2361x1568 · CFP:
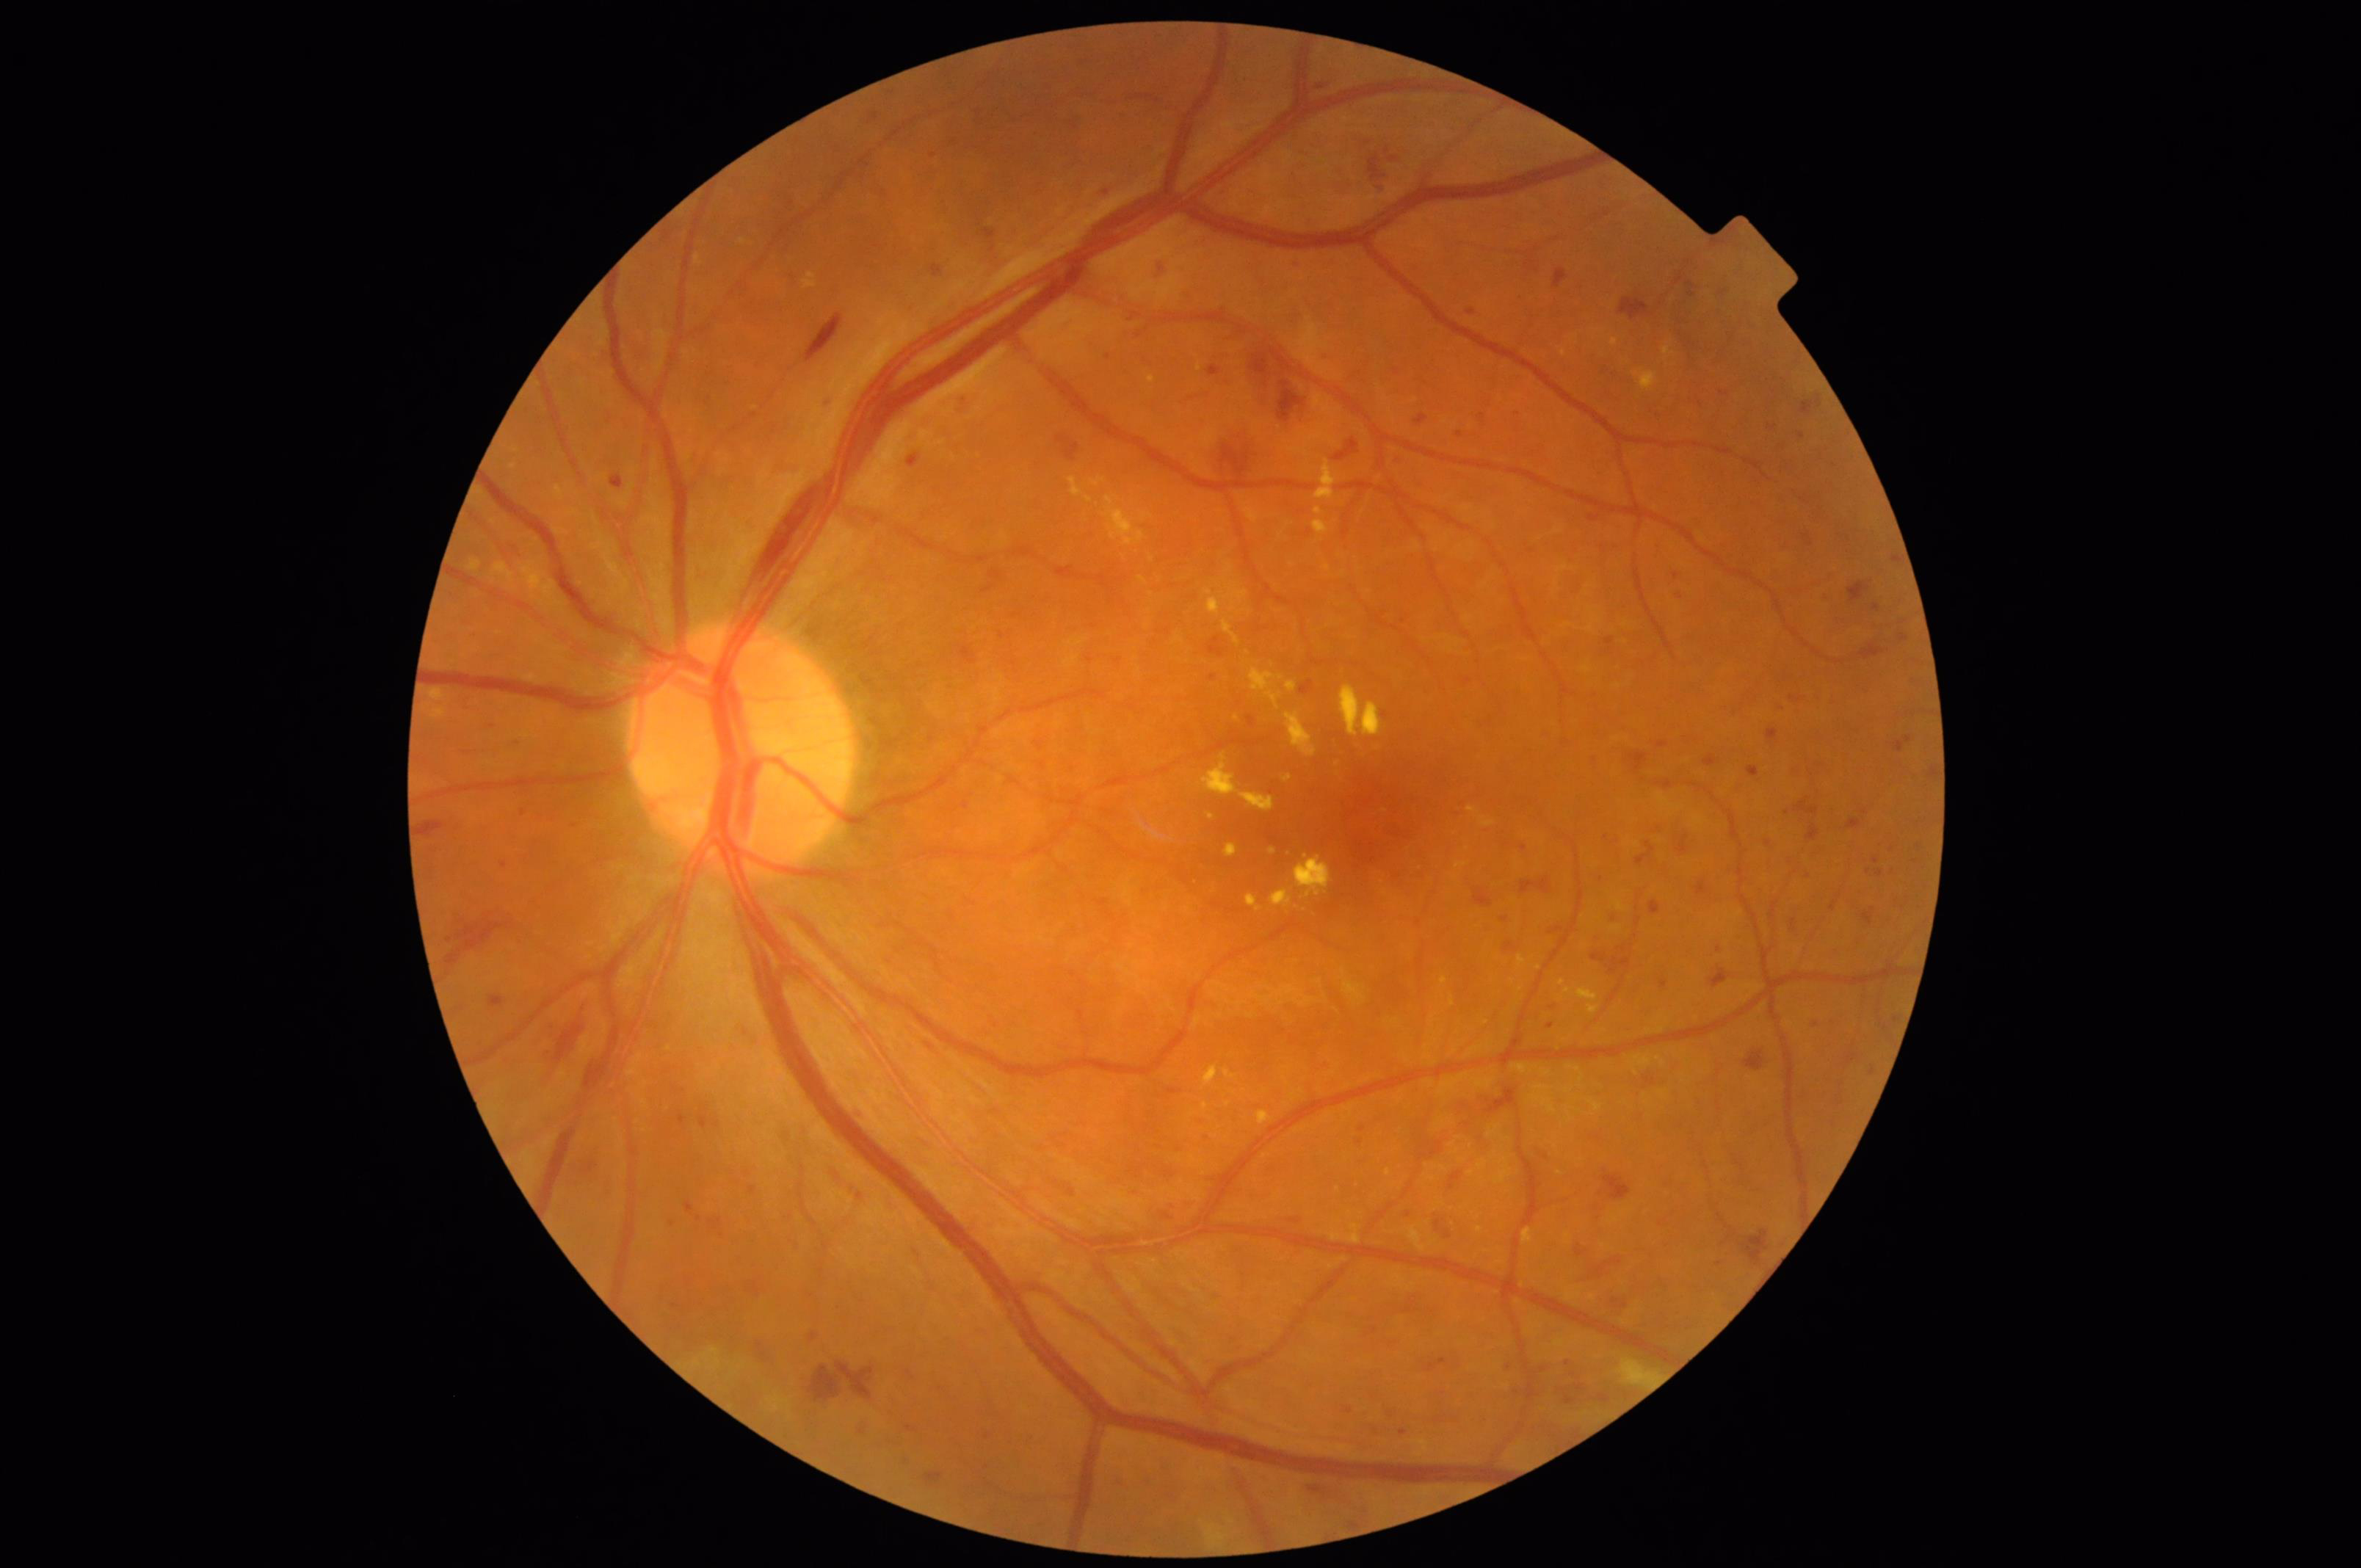
Illumination and color balance are good. Good dynamic range. Image is sharp throughout the field. Image quality is adequate for diagnostic use.